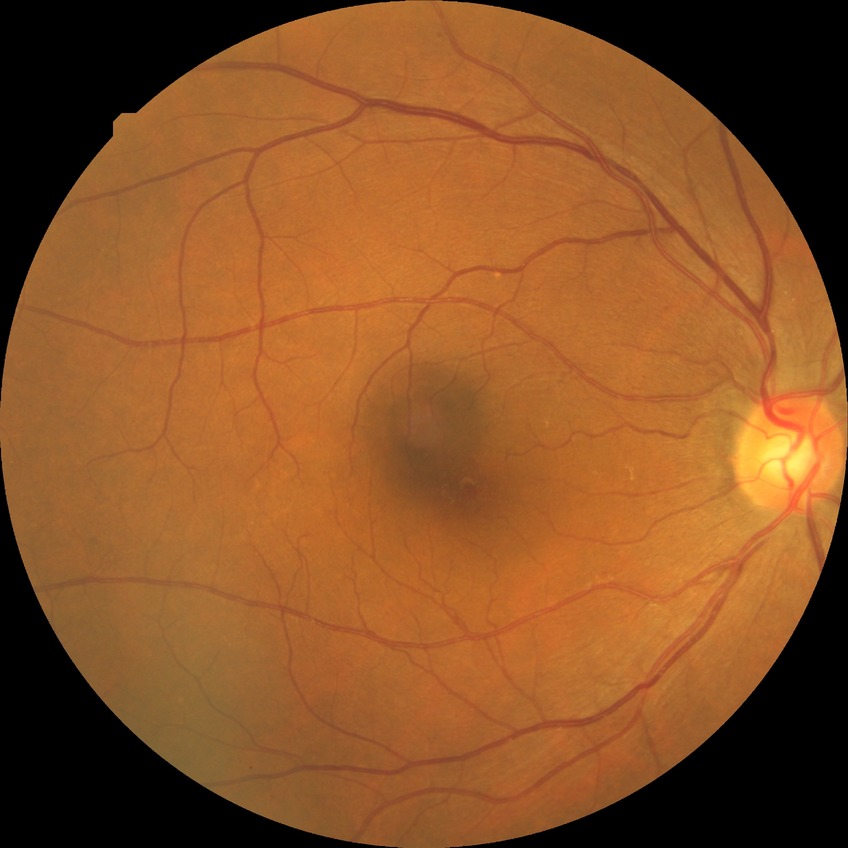 Diabetic retinopathy (DR) is no diabetic retinopathy (NDR).